Nidek AFC-330: 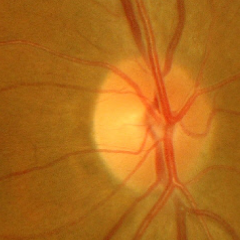

Glaucoma stage = early-stage glaucoma.